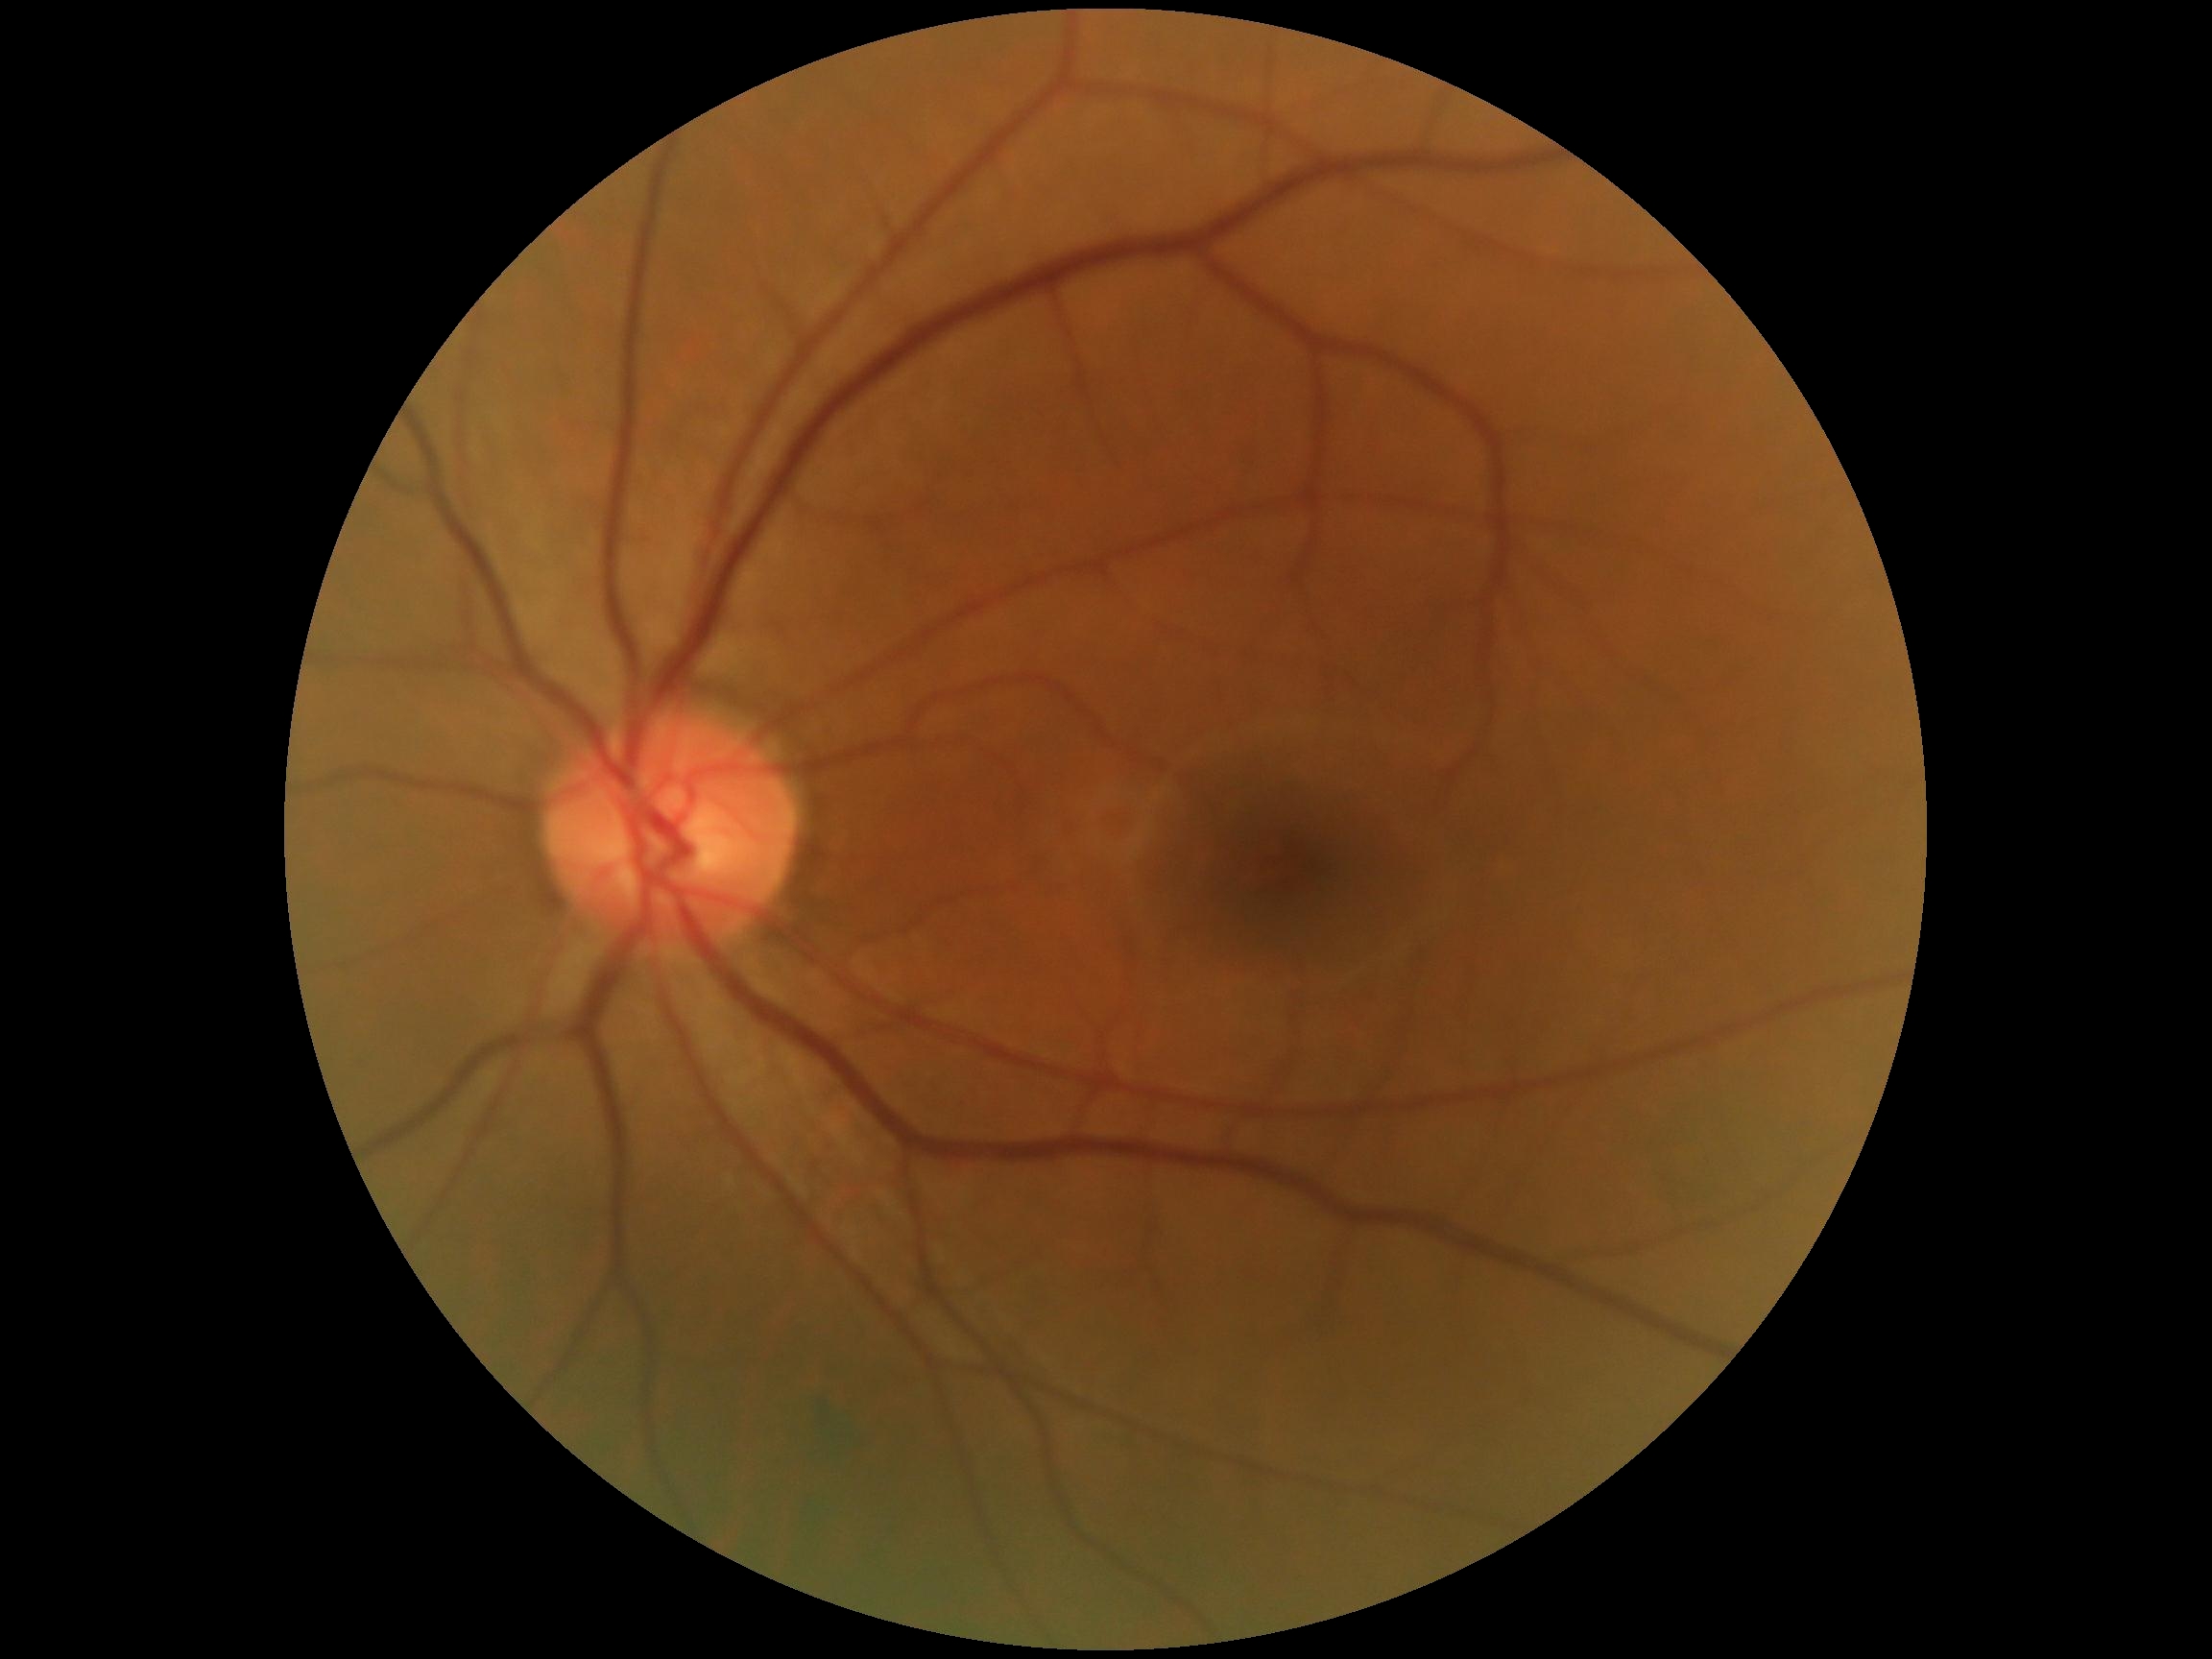

DR severity is no apparent diabetic retinopathy (grade 0).